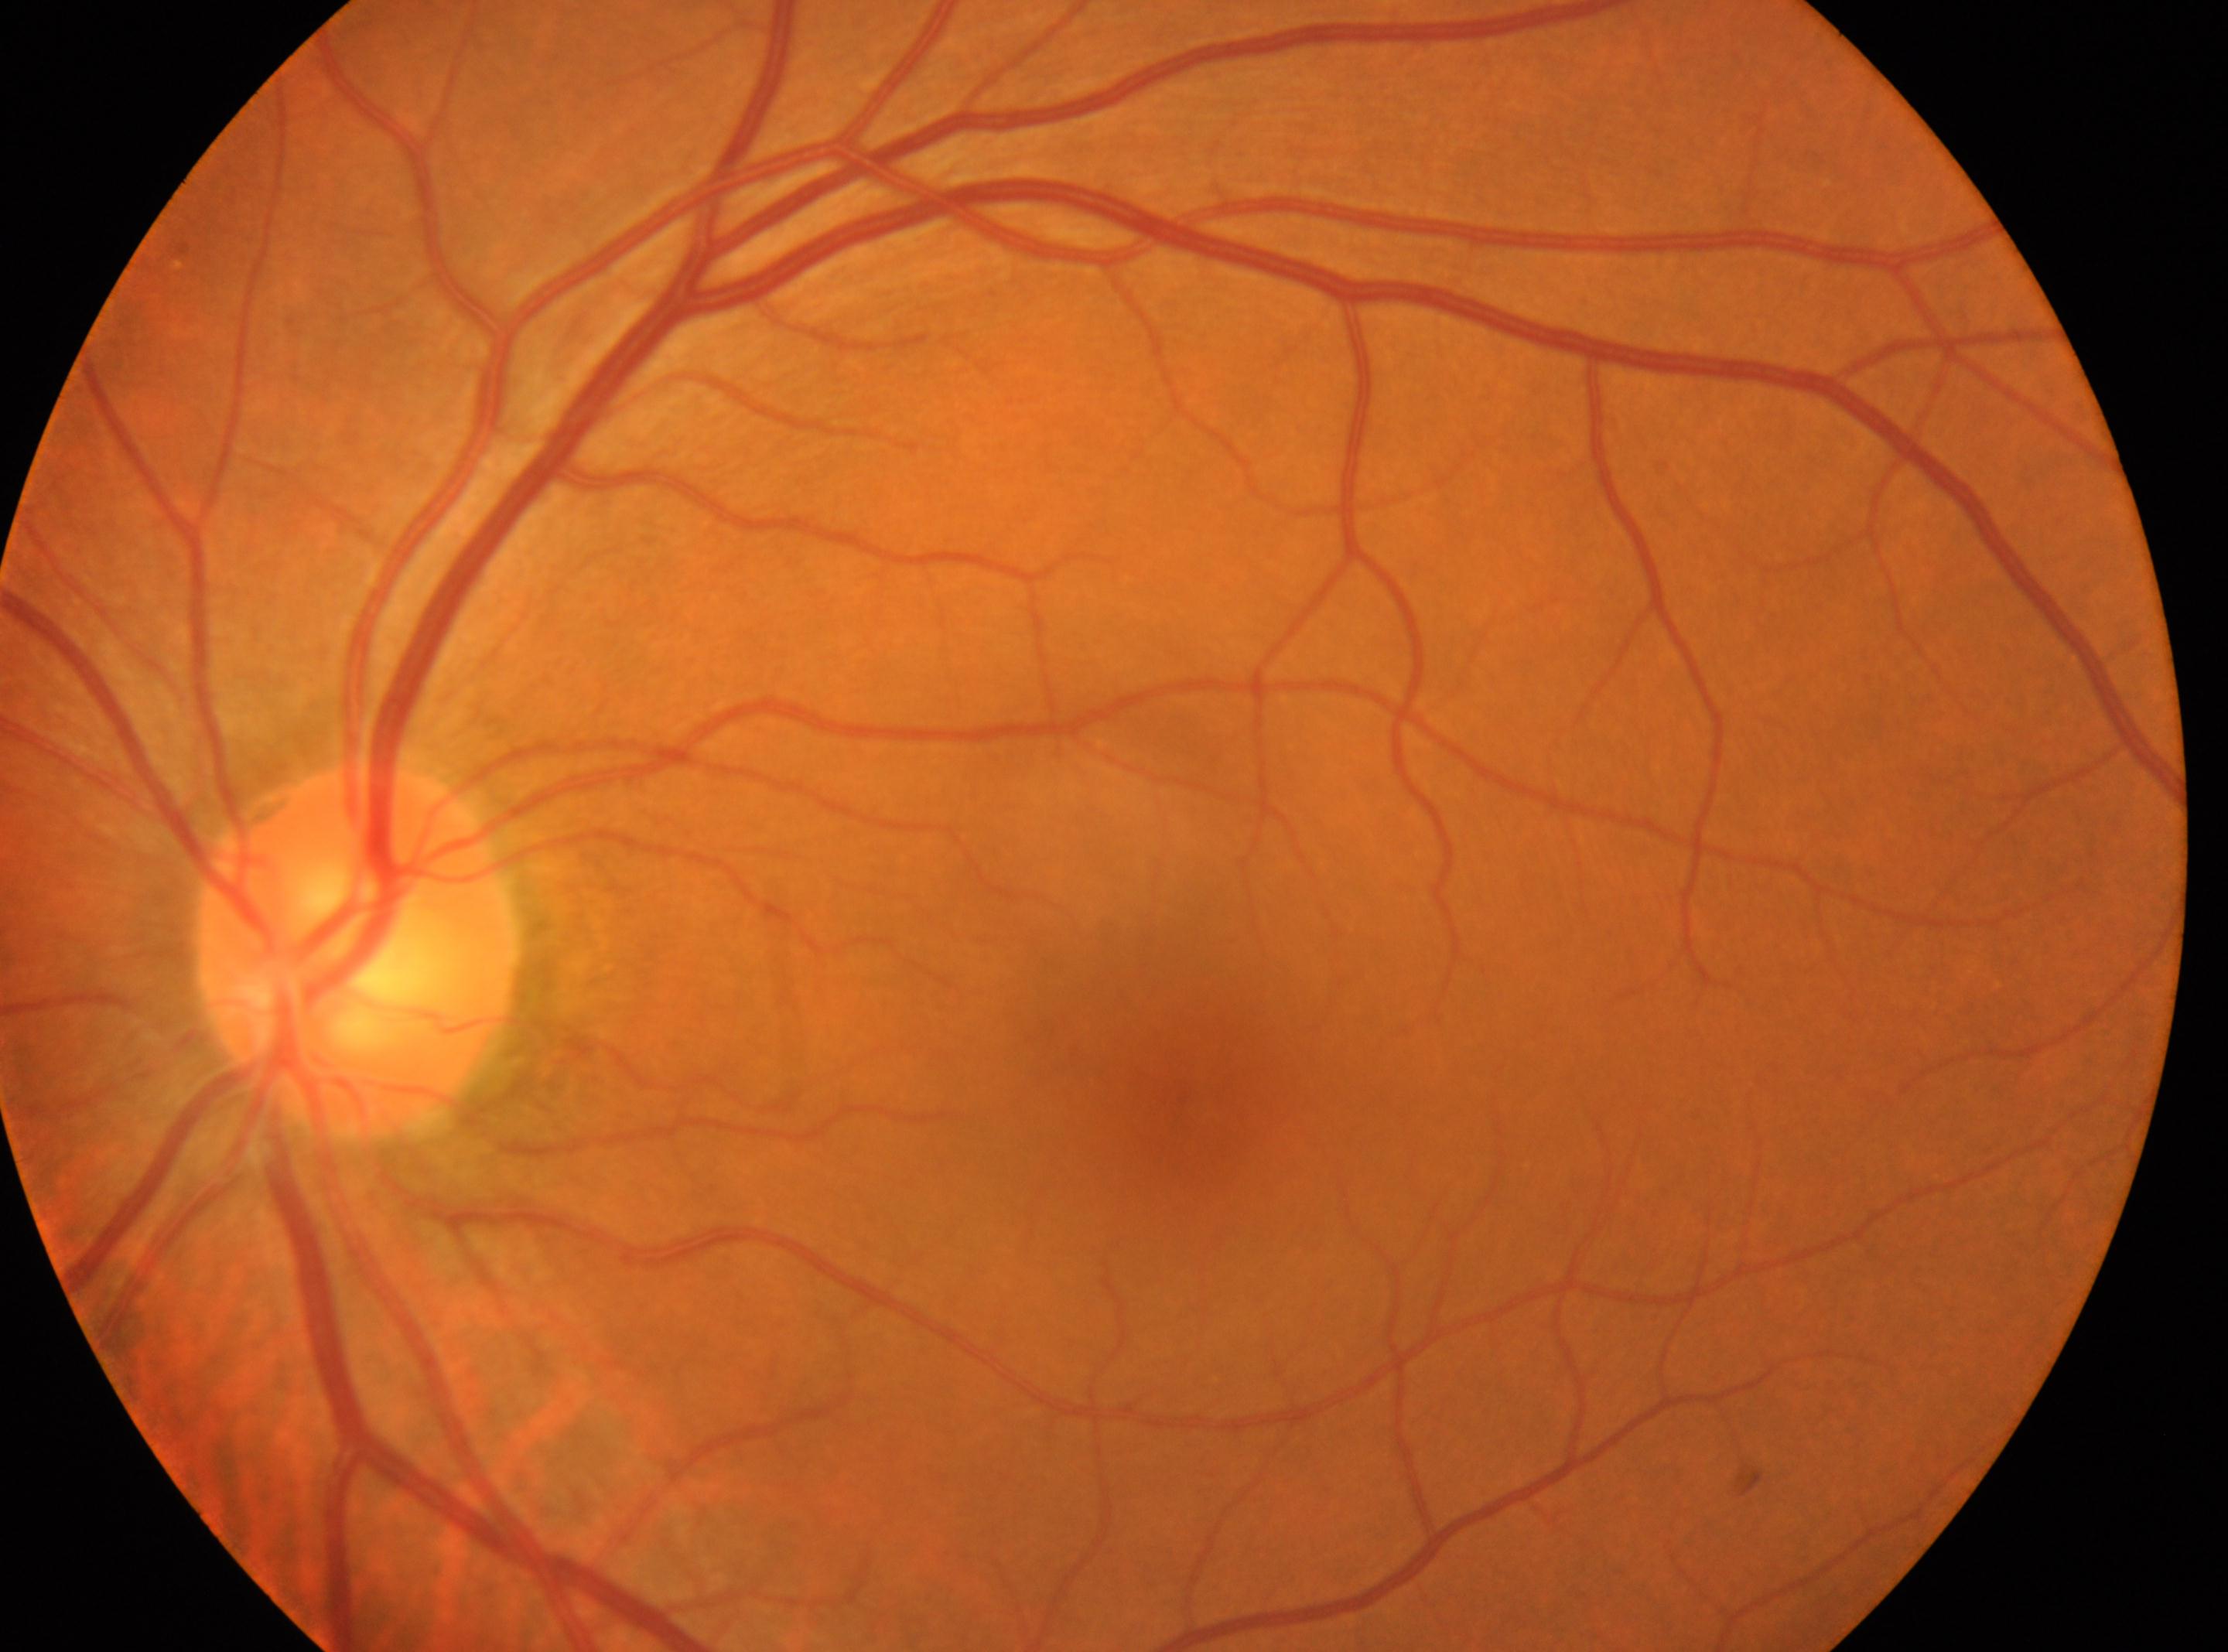
laterality: left; fovea: x=1196, y=1108; optic disk: x=357, y=947; diabetic retinopathy (DR): grade 0 (no apparent retinopathy).